Natus RetCam Envision, 130° FOV. Wide-field fundus image from infant ROP screening:
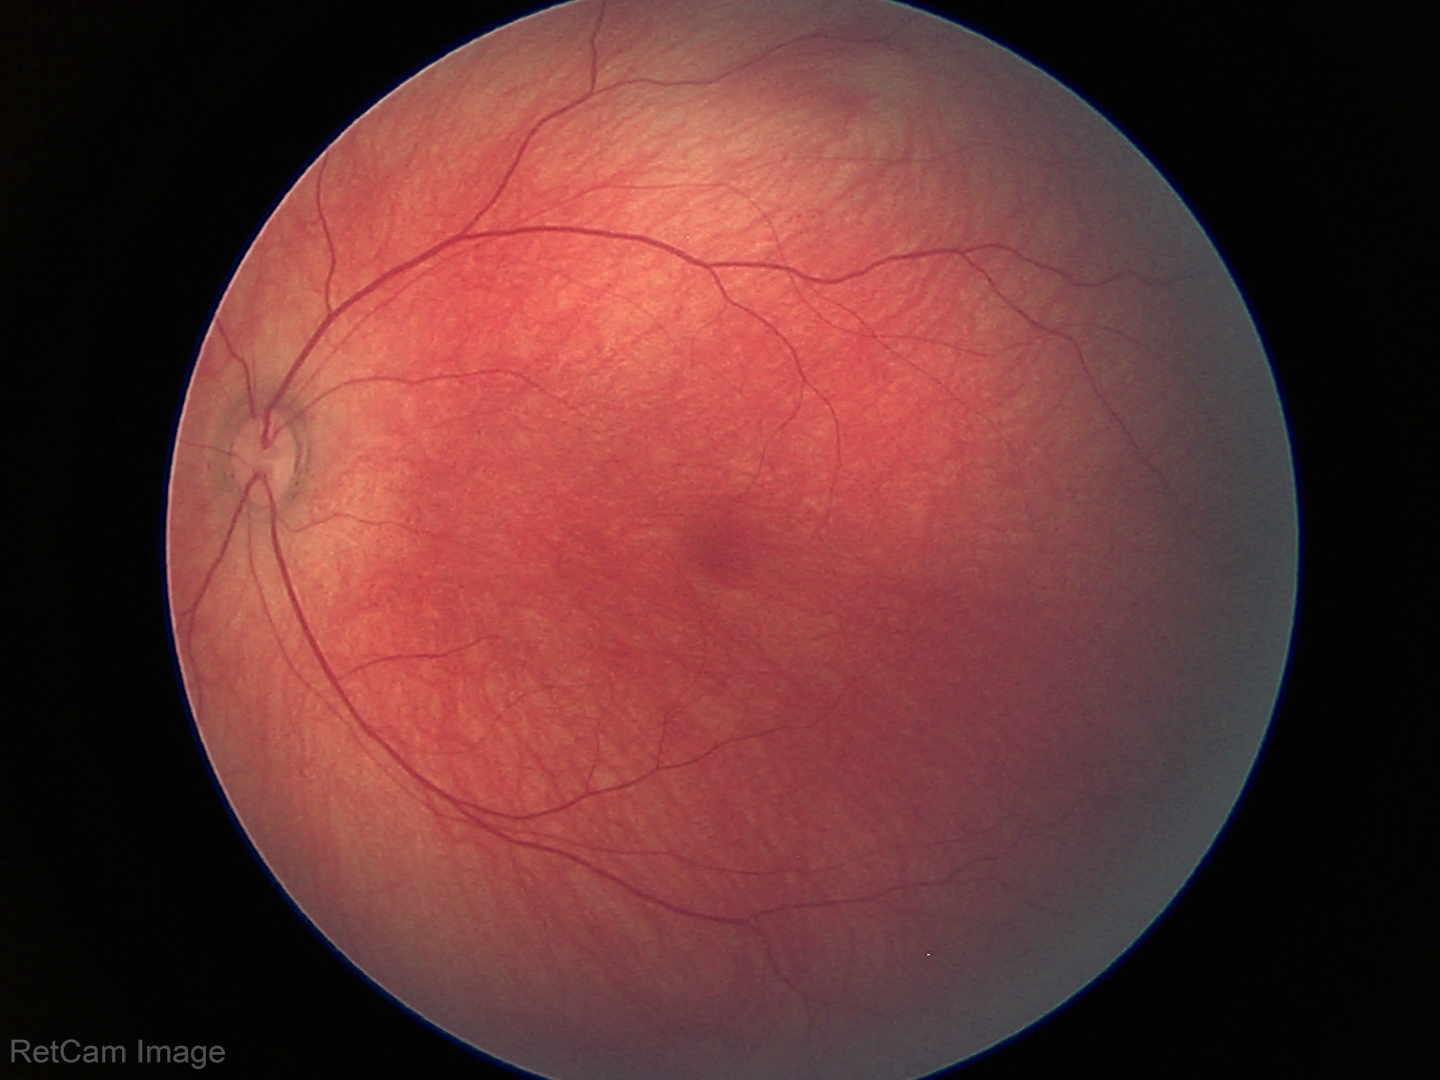
Screening: no abnormal retinal findings.